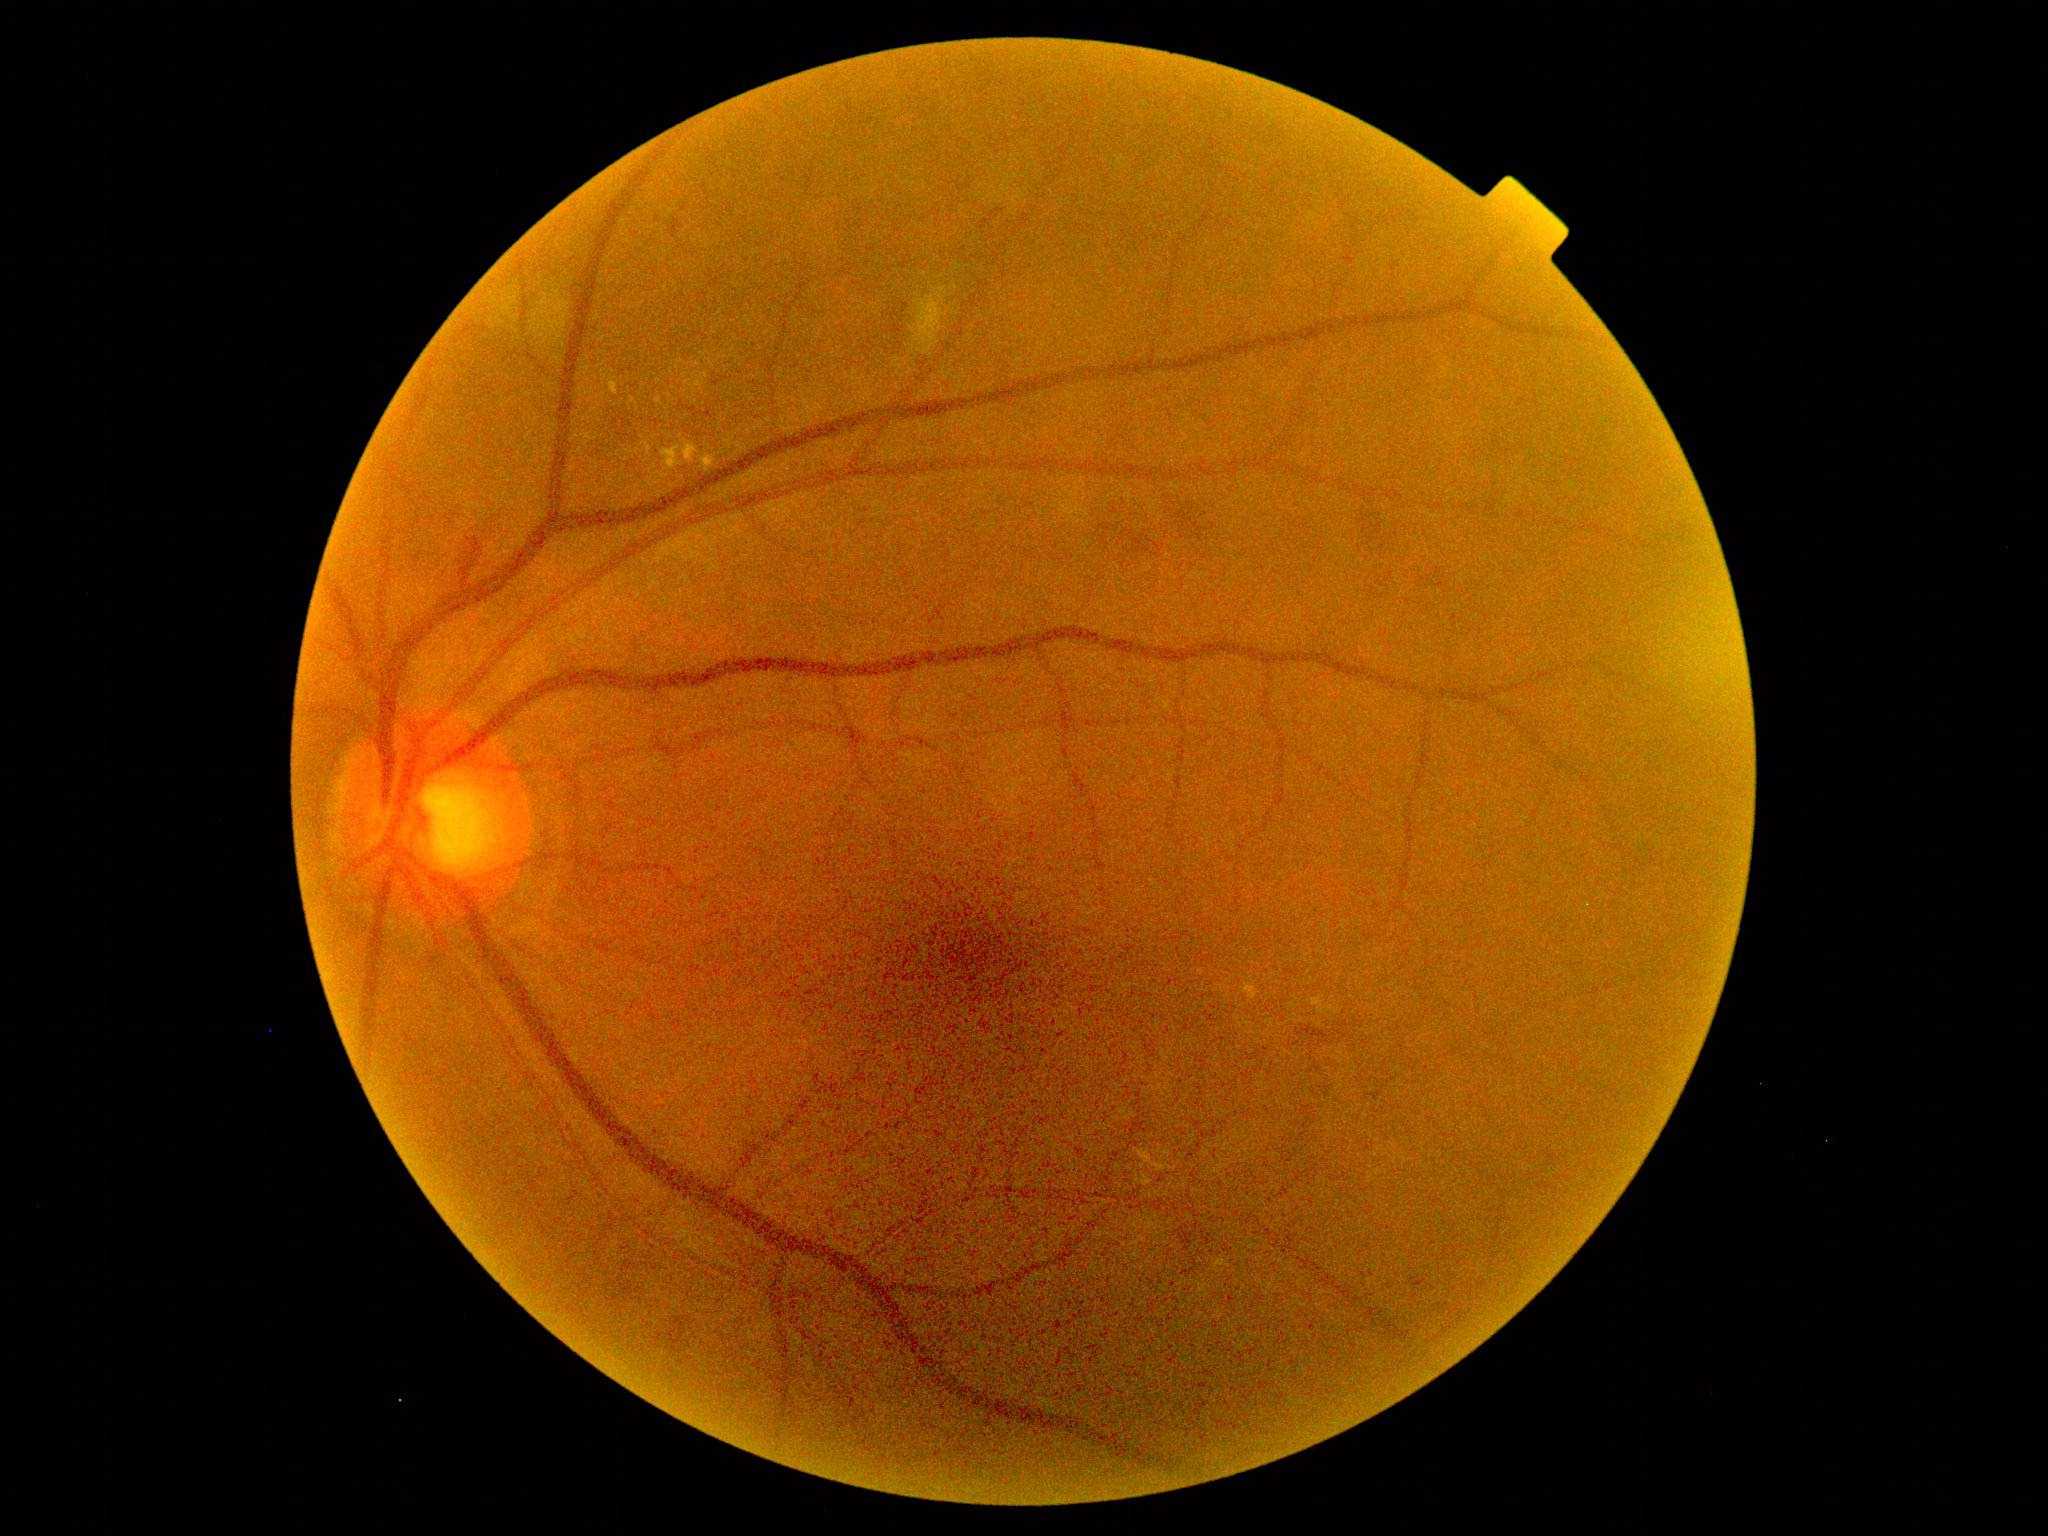
{"dr_grade": "grade 2 (moderate NPDR)"}